No pharmacologic dilation, modified Davis grading, 848x848px: 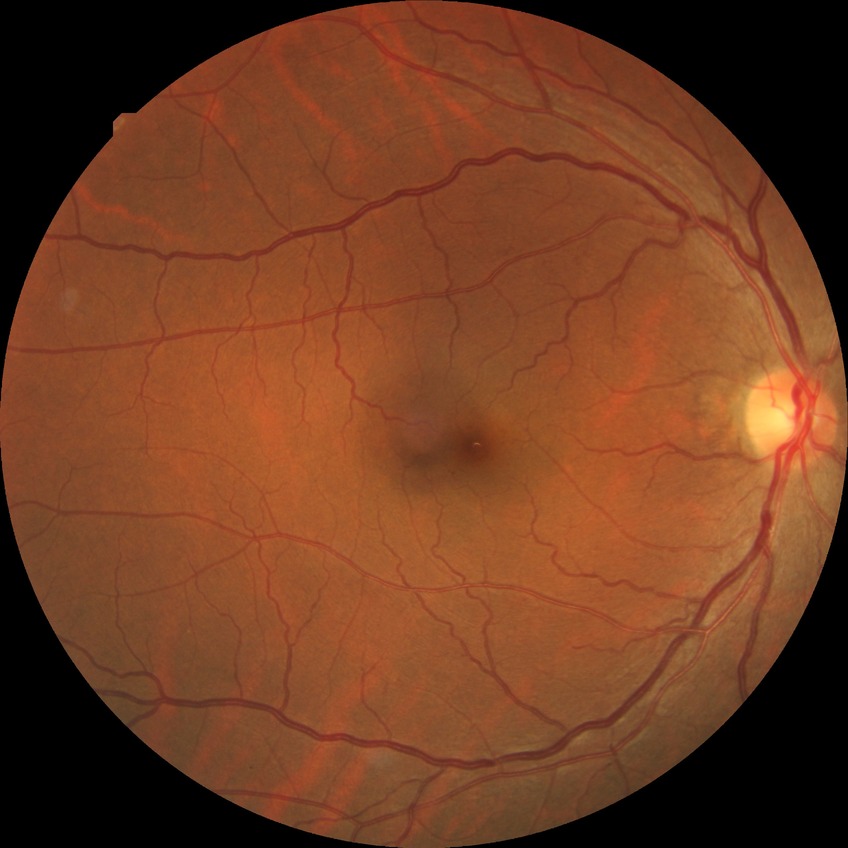
Modified Davis grading: no diabetic retinopathy.